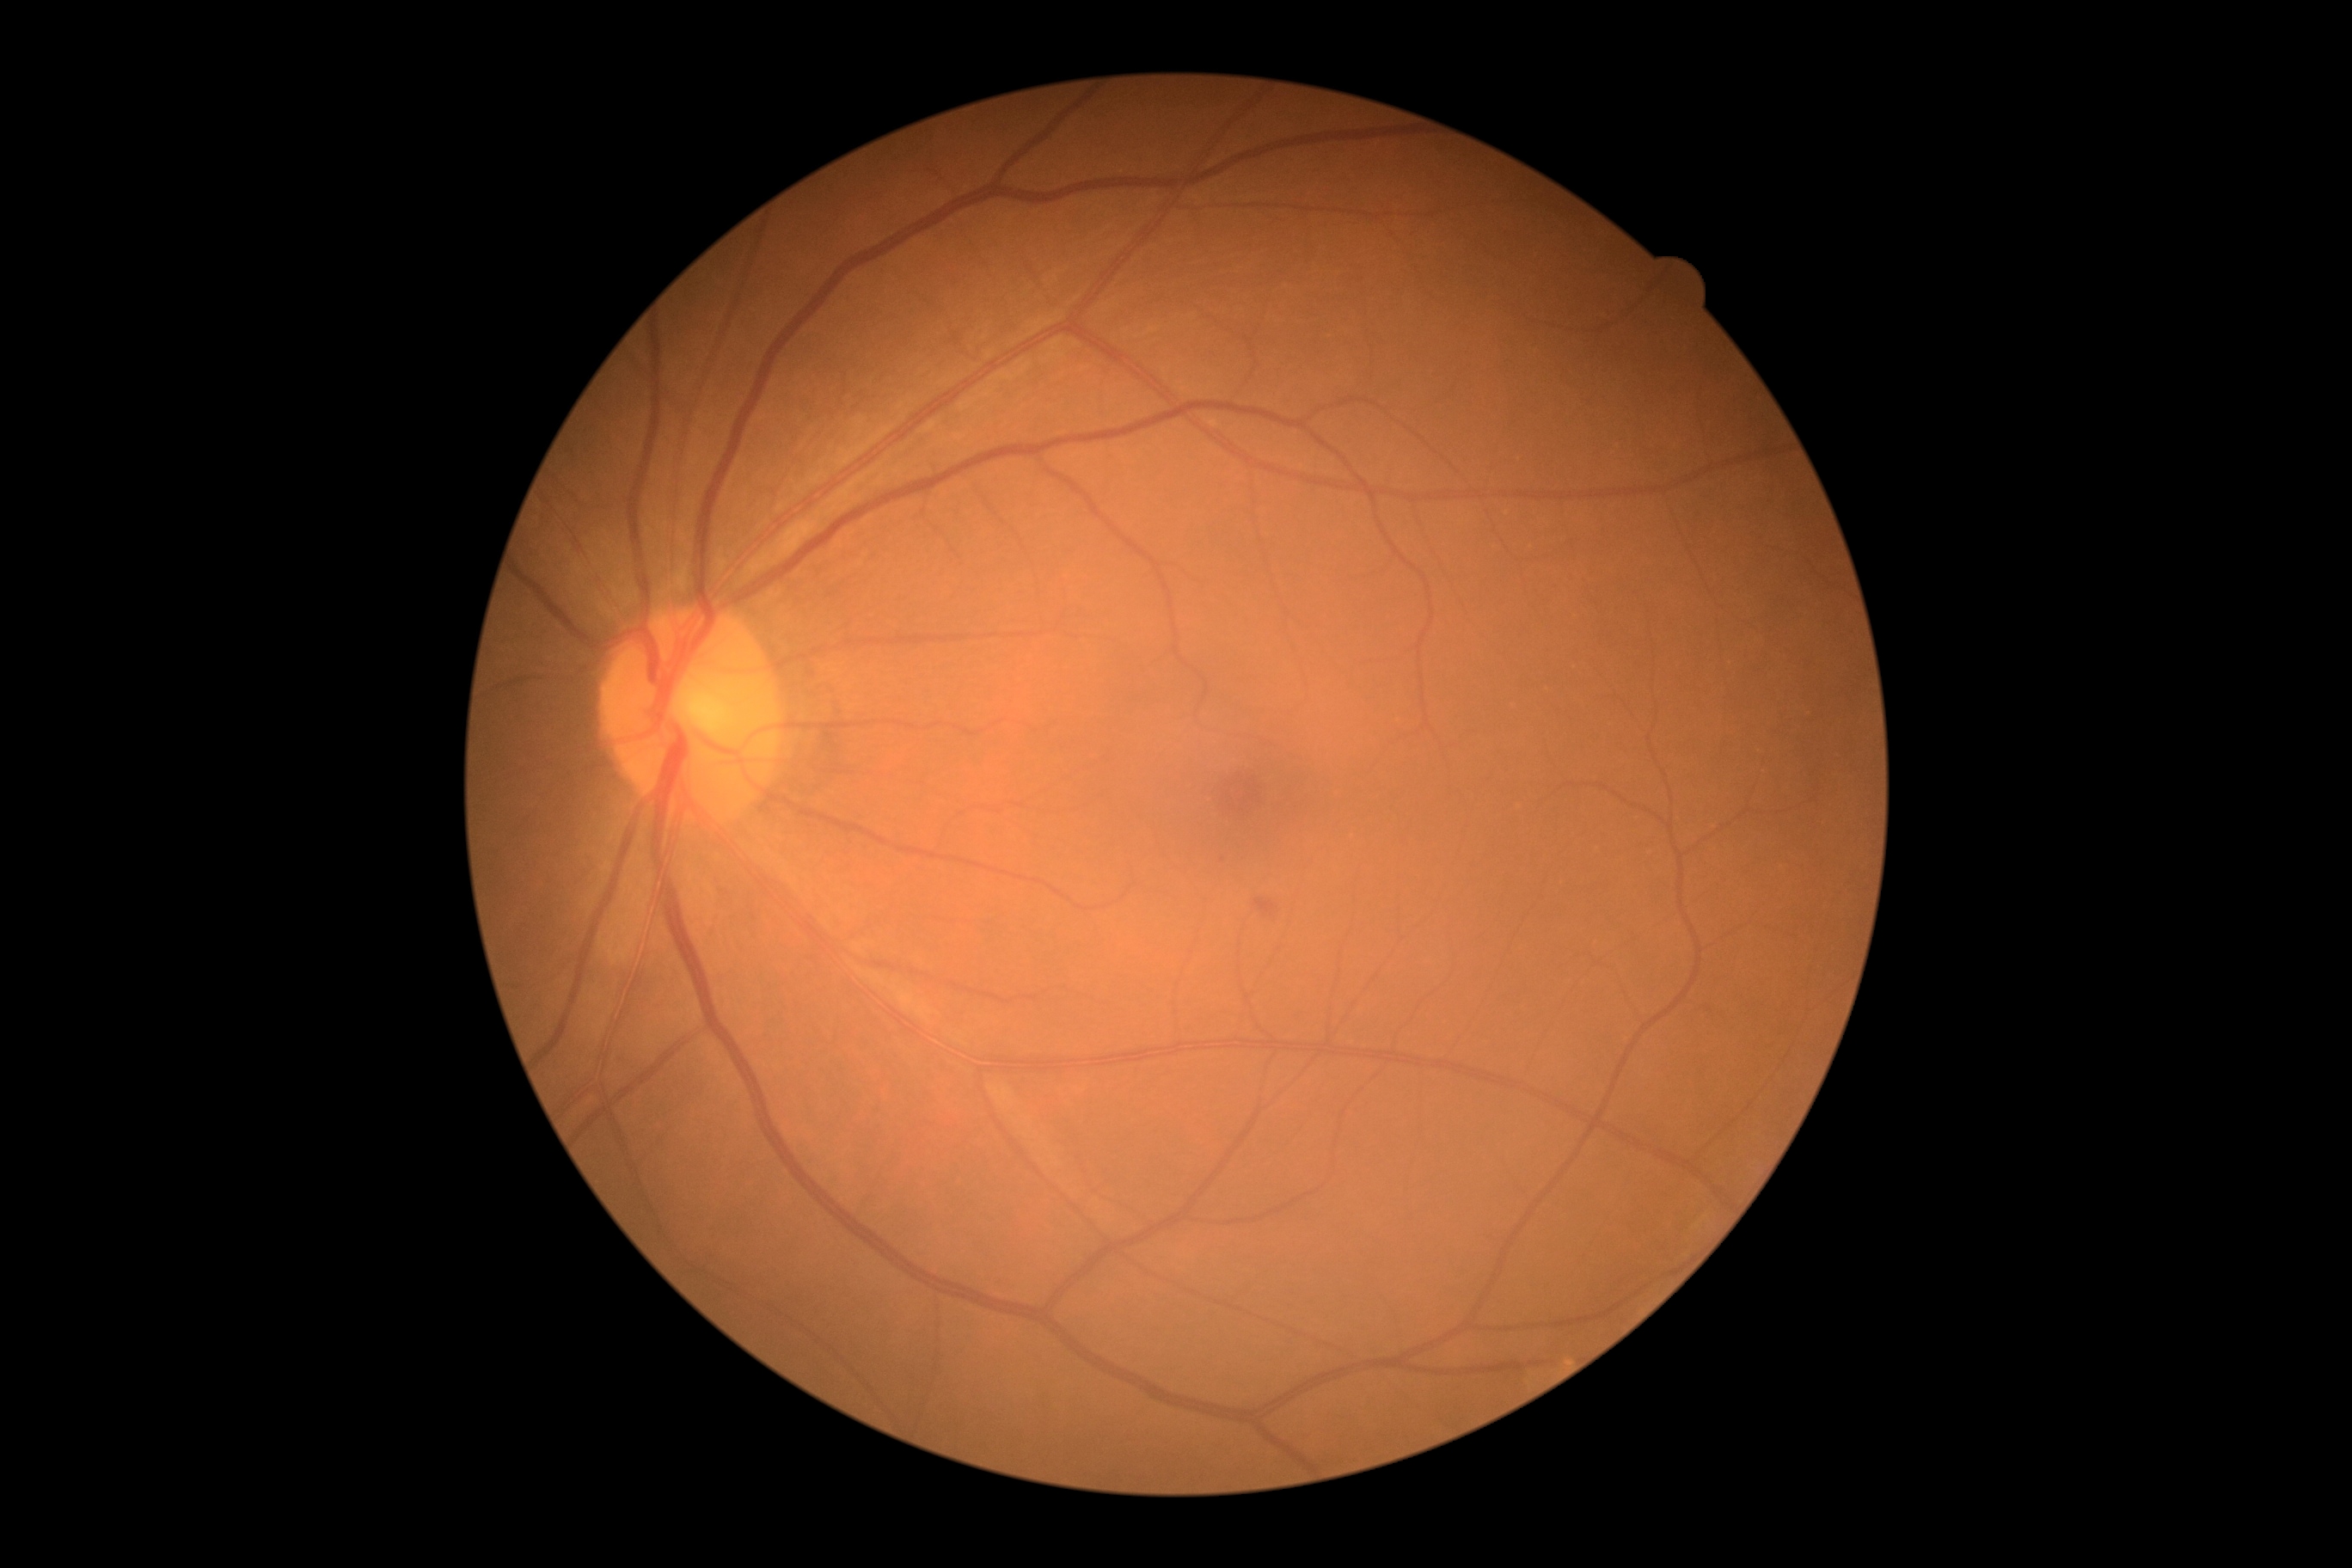

Diabetic retinopathy (DR) is 2/4.